Image size 848x848; posterior pole photograph
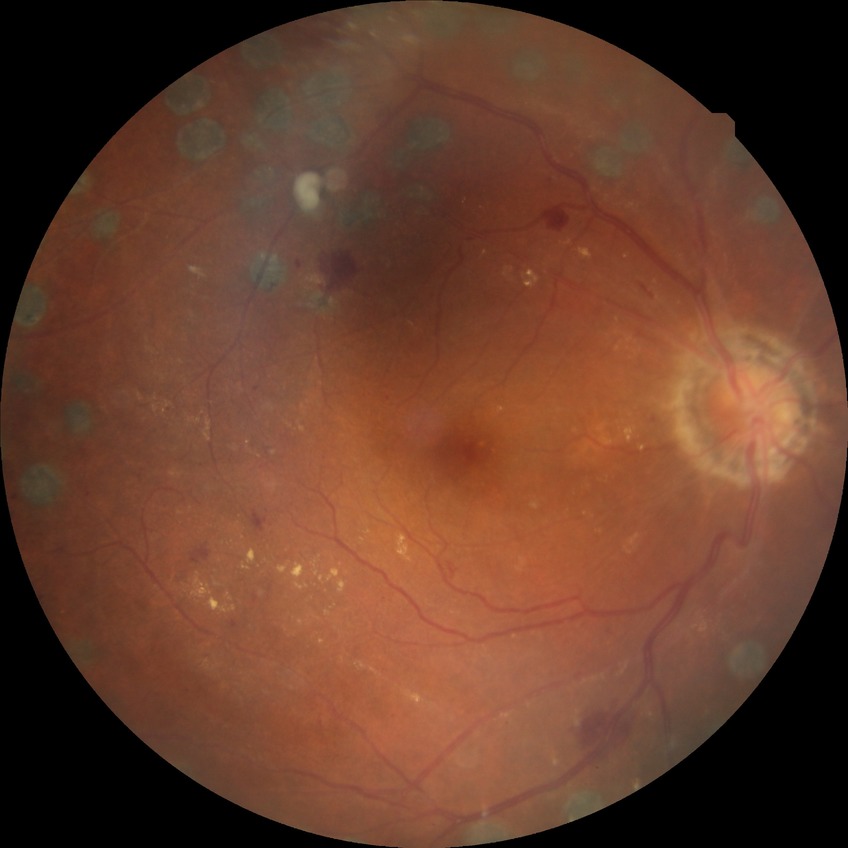 Diabetic retinopathy (DR): PDR (proliferative diabetic retinopathy).